Optic disc photograph
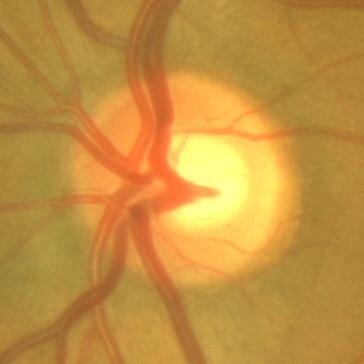 The image shows no evidence of glaucoma.